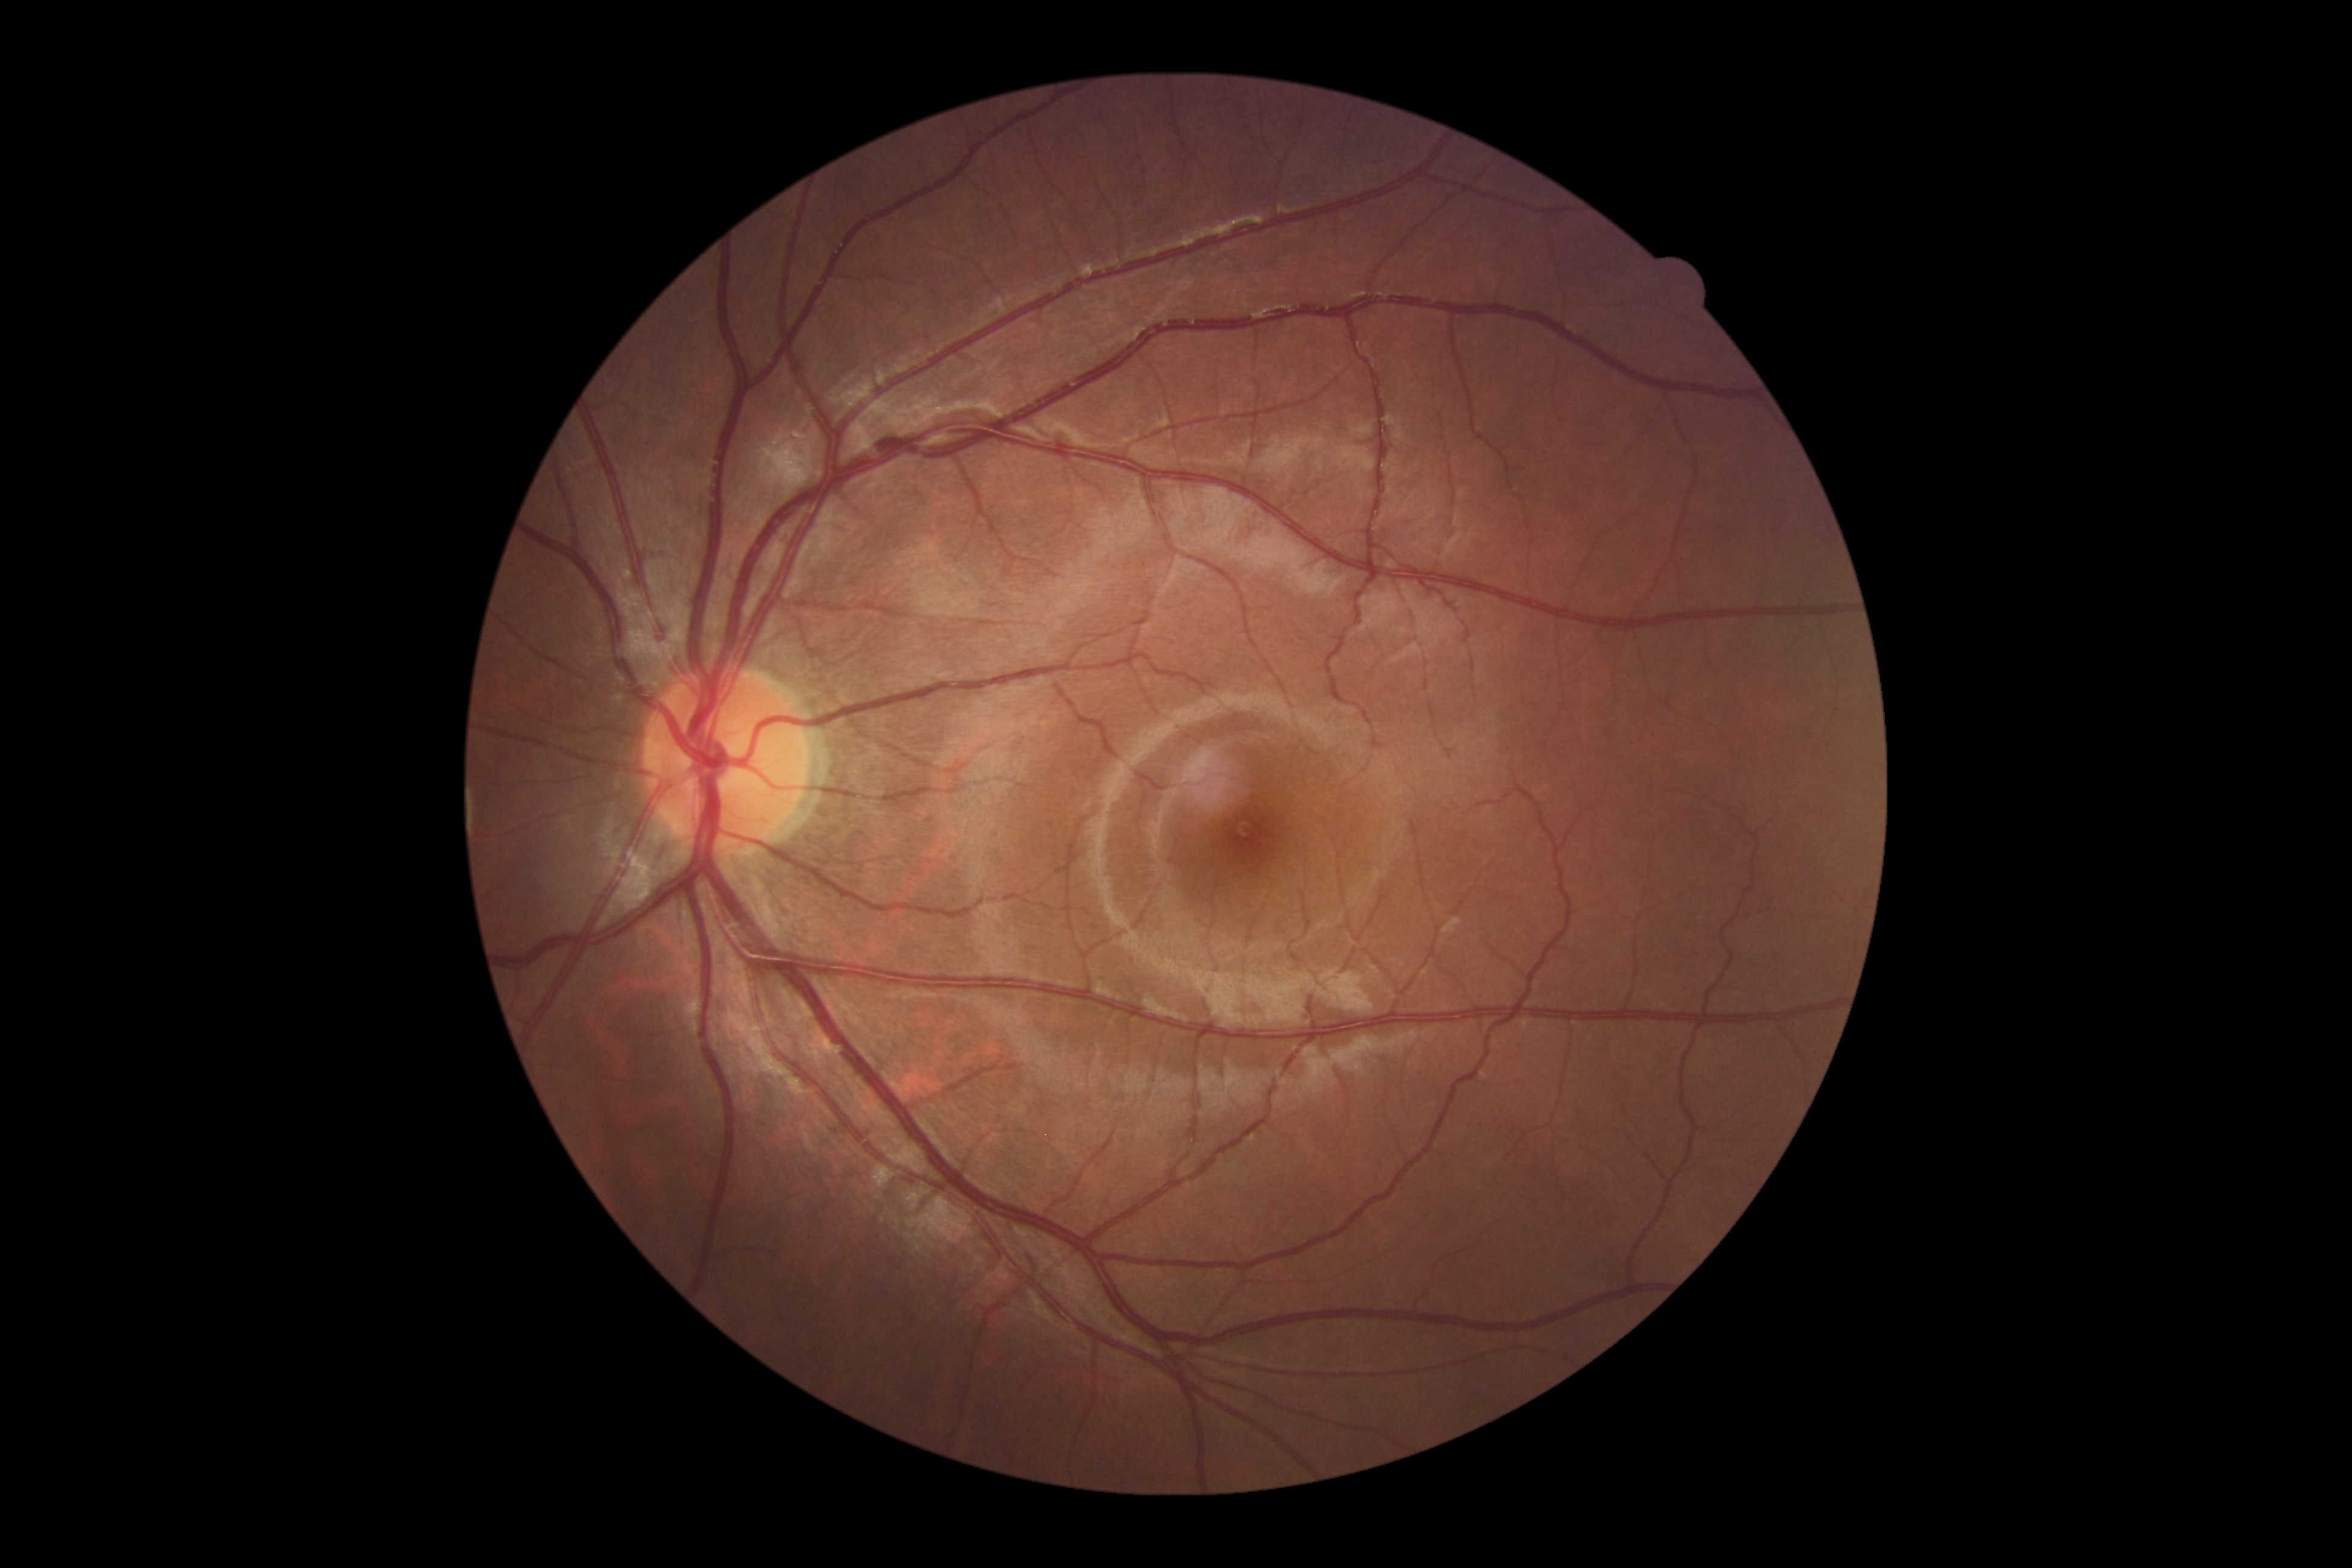

DR grade is no apparent retinopathy (0).
No DR findings.